130° field of view (Clarity RetCam 3). Pediatric wide-field fundus photograph.
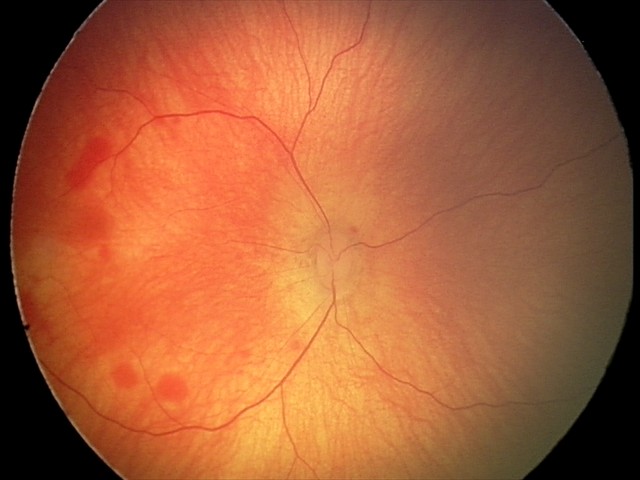 Diagnosis from this screening exam: retinal hemorrhages.